Infant wide-field retinal image. 1240 by 1240 pixels. 100° field of view (Phoenix ICON) — 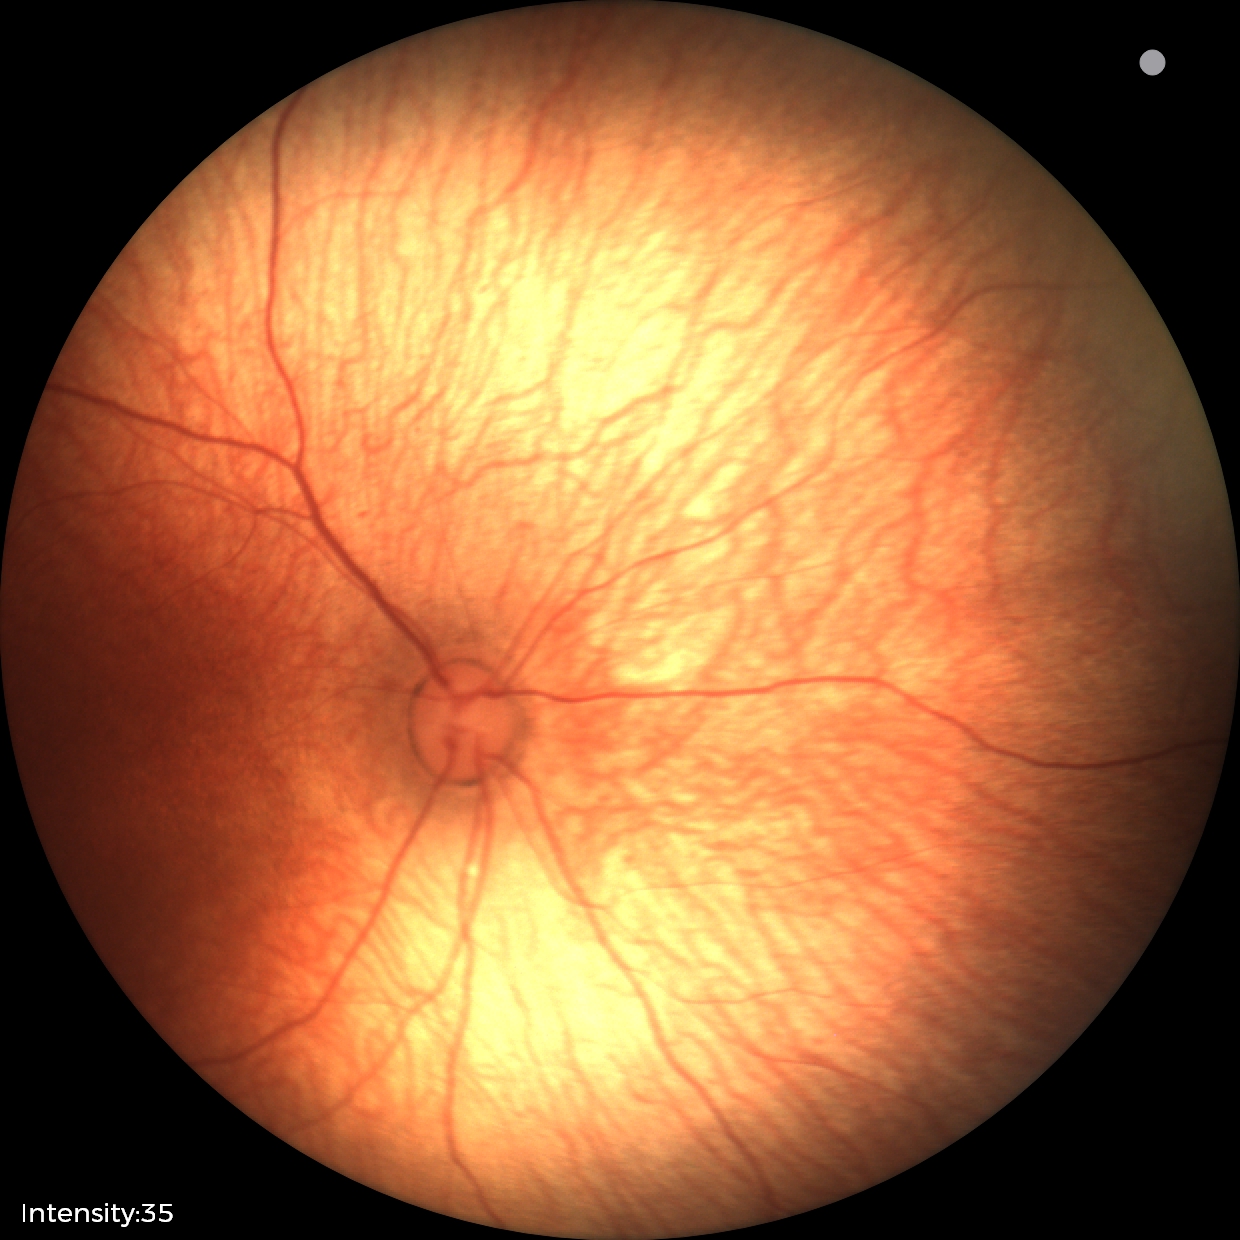
No retinal pathology identified on screening.